Infant wide-field retinal image; captured with the Clarity RetCam 3 (130° field of view).
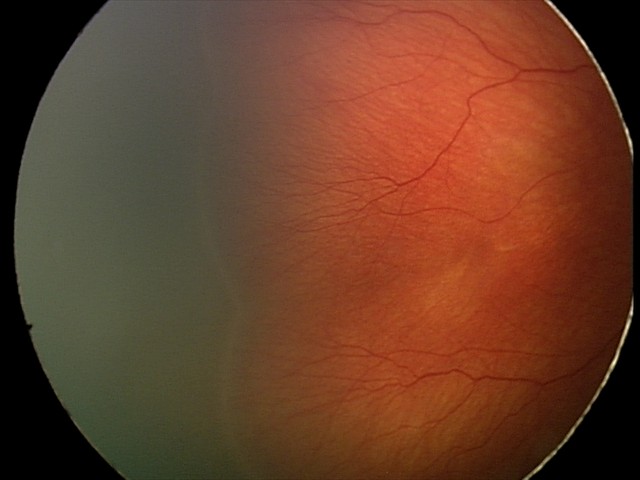
No plus disease. Screening series with retinopathy of prematurity stage 2.